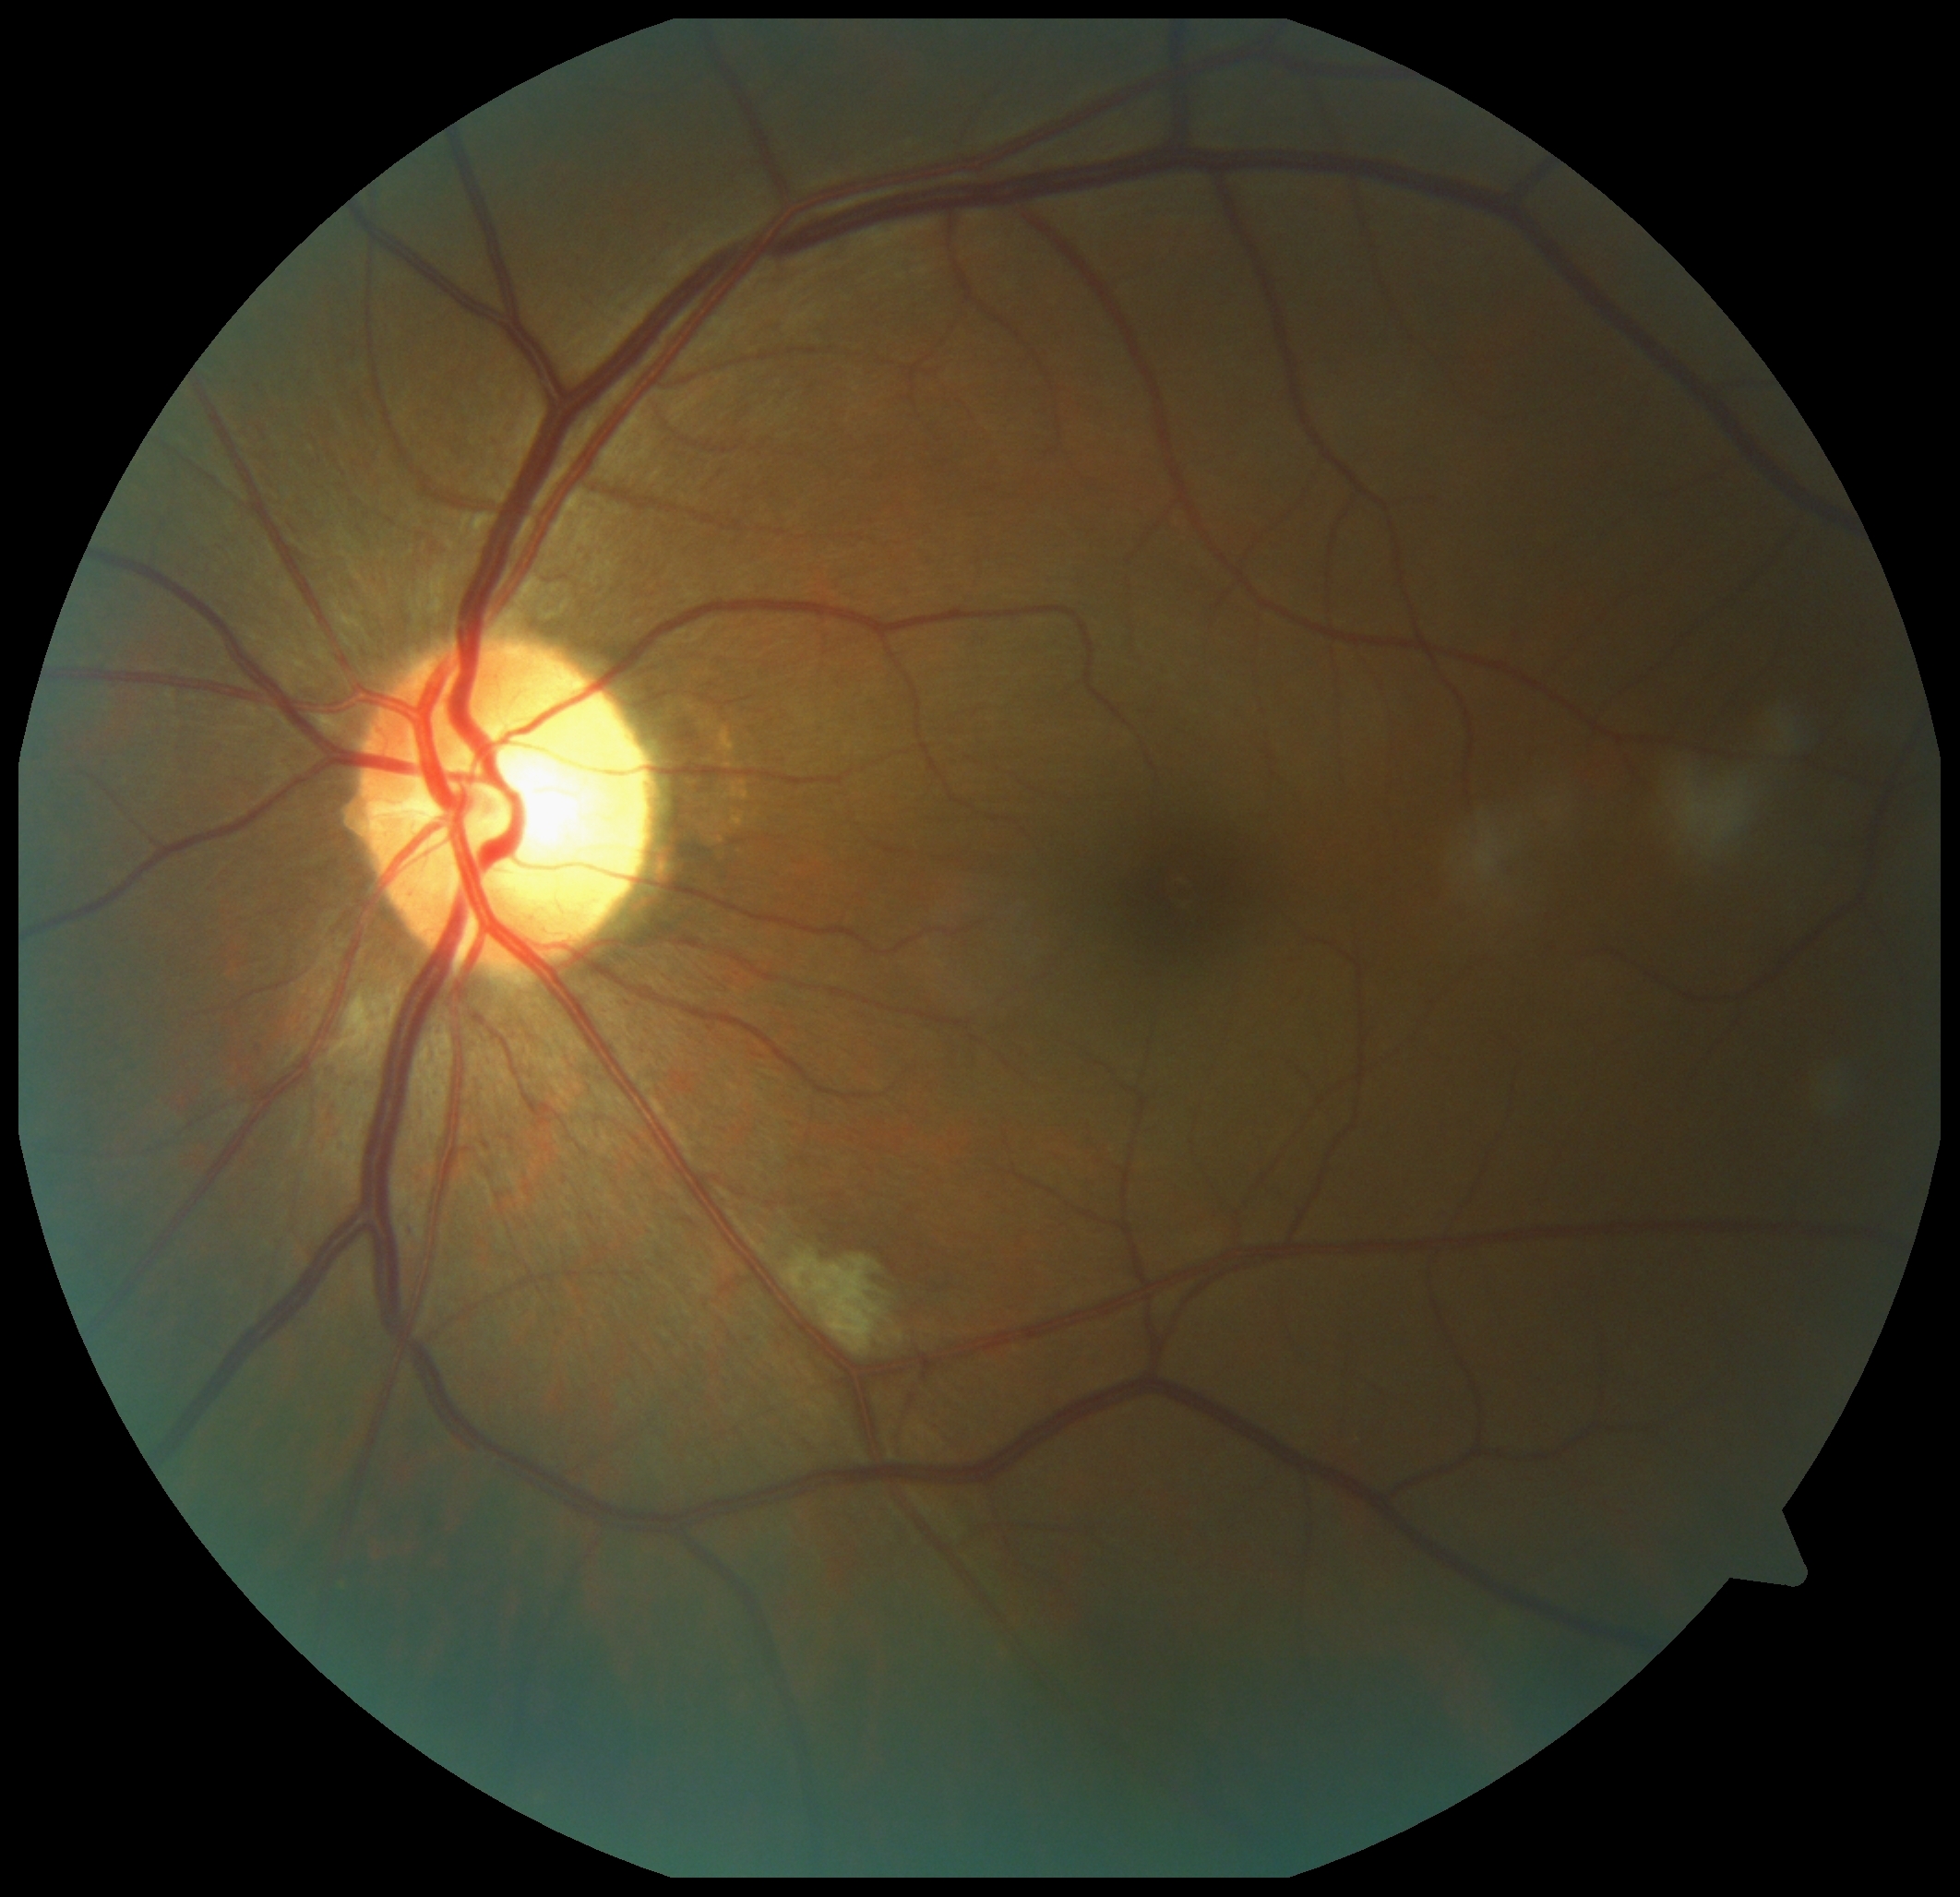 DR class = non-proliferative diabetic retinopathy; diabetic retinopathy severity = grade 2.